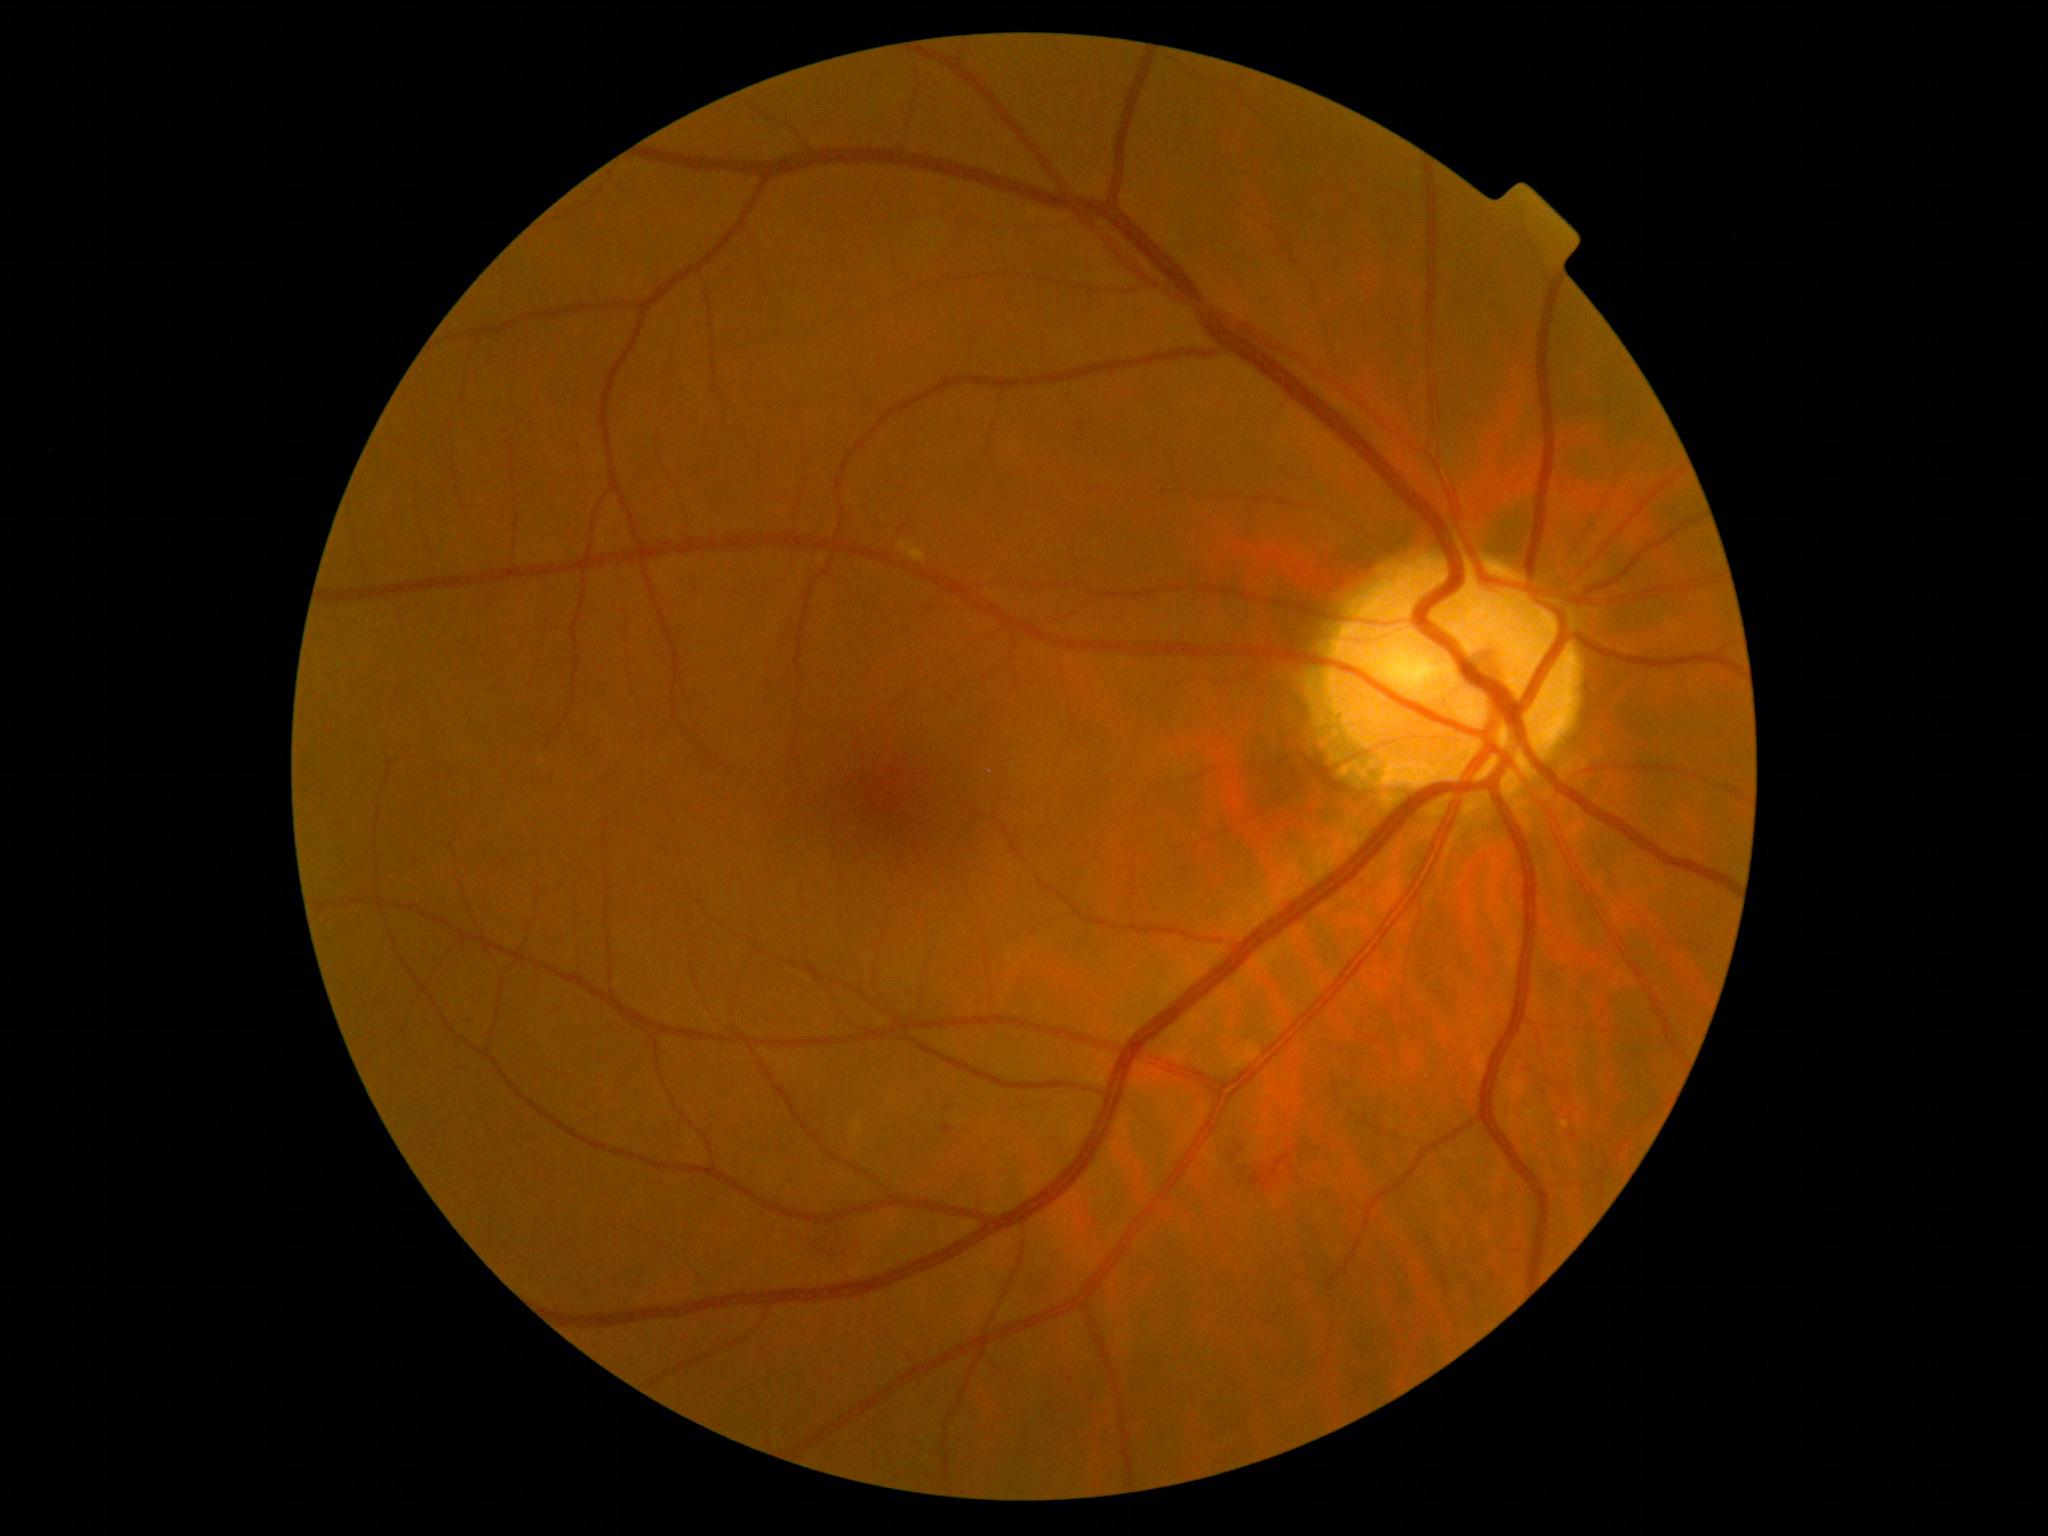
DR grade: 2.